NIDEK AFC-230; nonmydriatic; 45 degree fundus photograph; 848x848px.
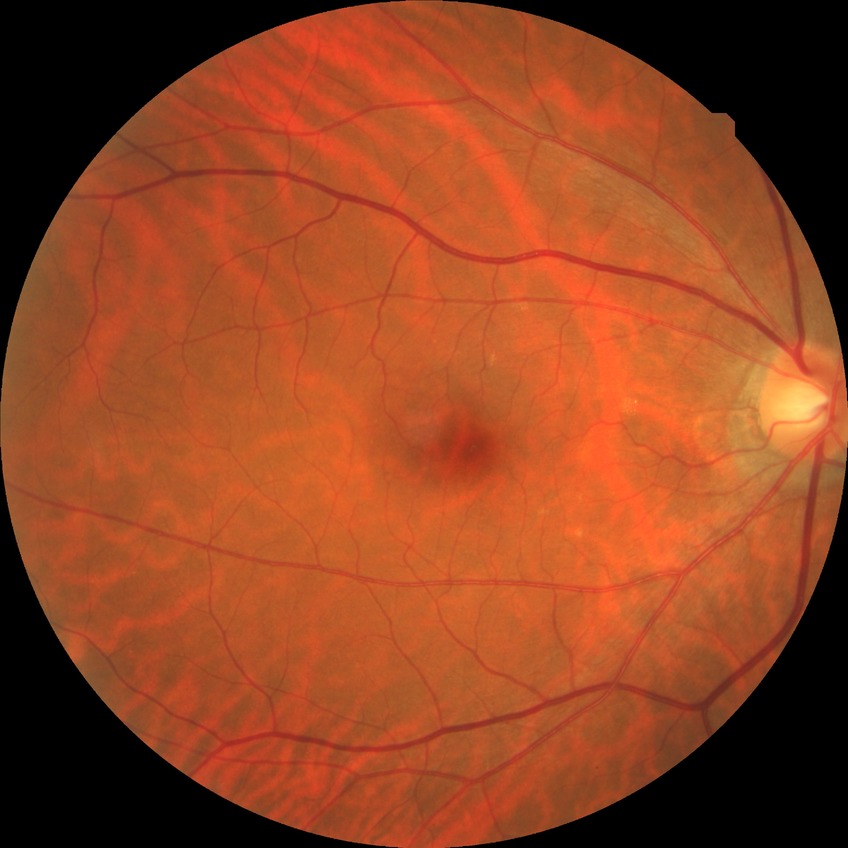
Diabetic retinopathy (DR) is no diabetic retinopathy (NDR).